Color fundus photograph from a handheld portable camera
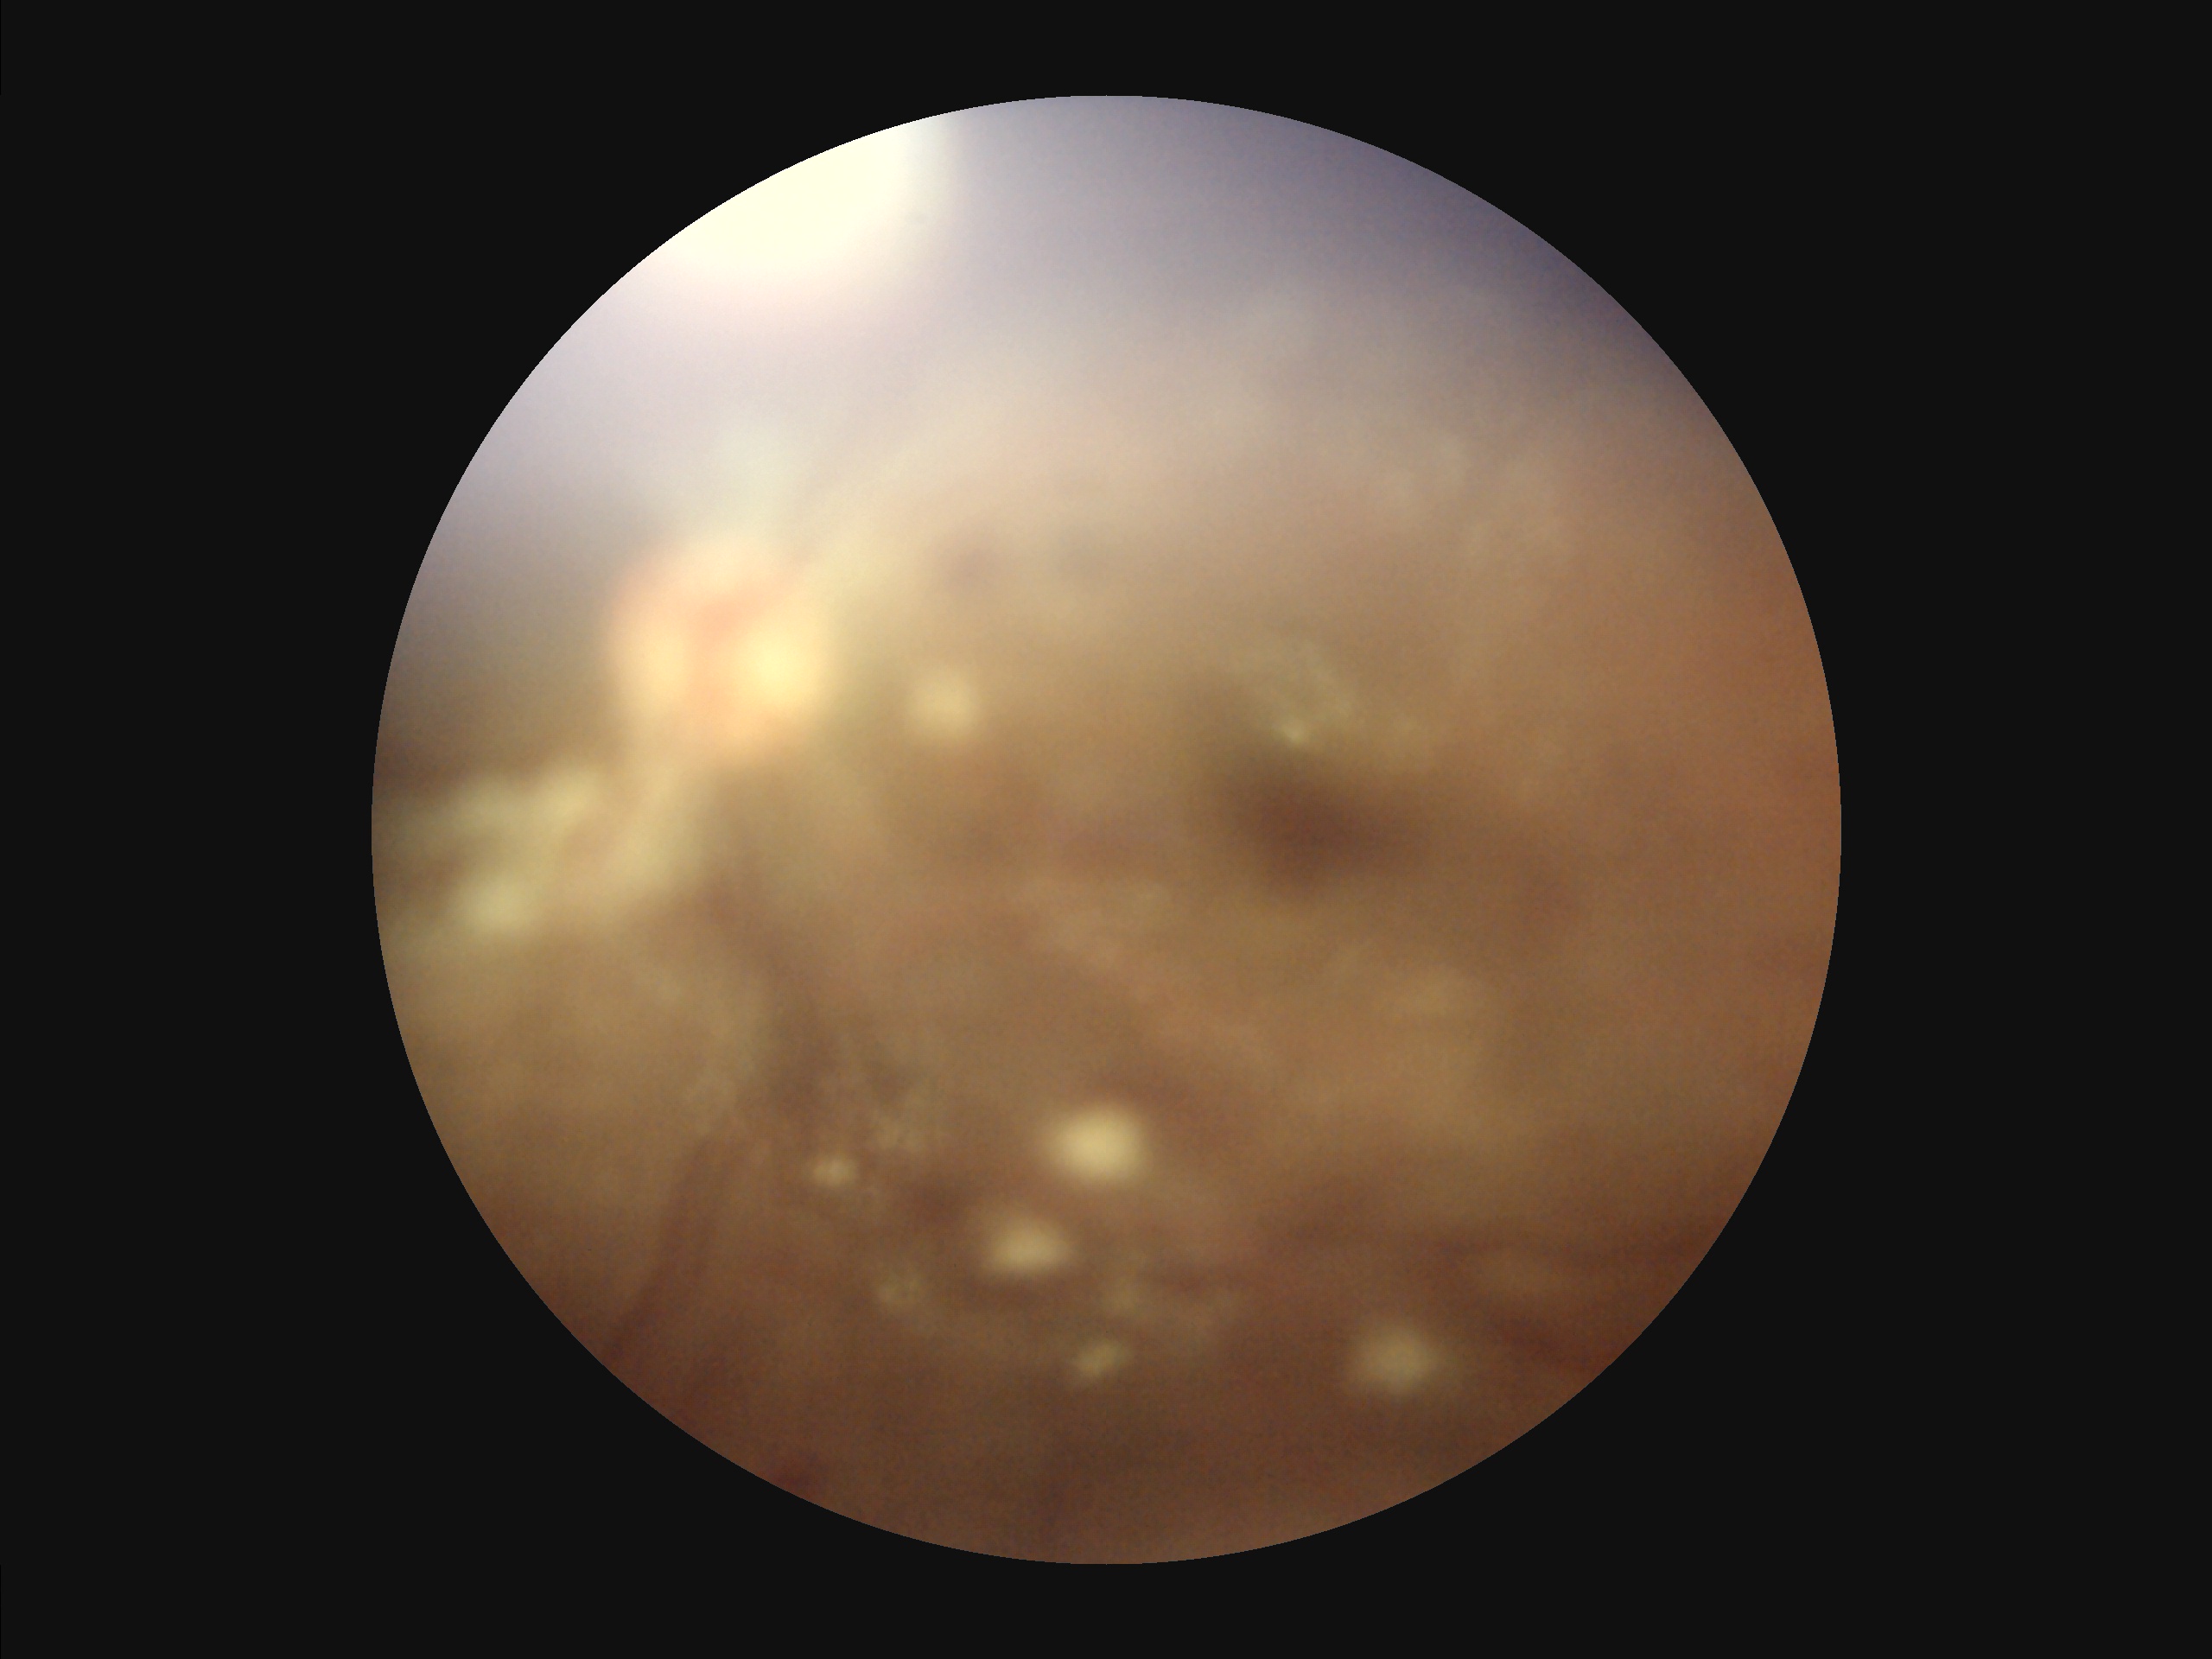

Overall quality is poor; the image is difficult to grade.
Reduced sharpness with visible blur.
Contrast is low.
Illumination is uneven.